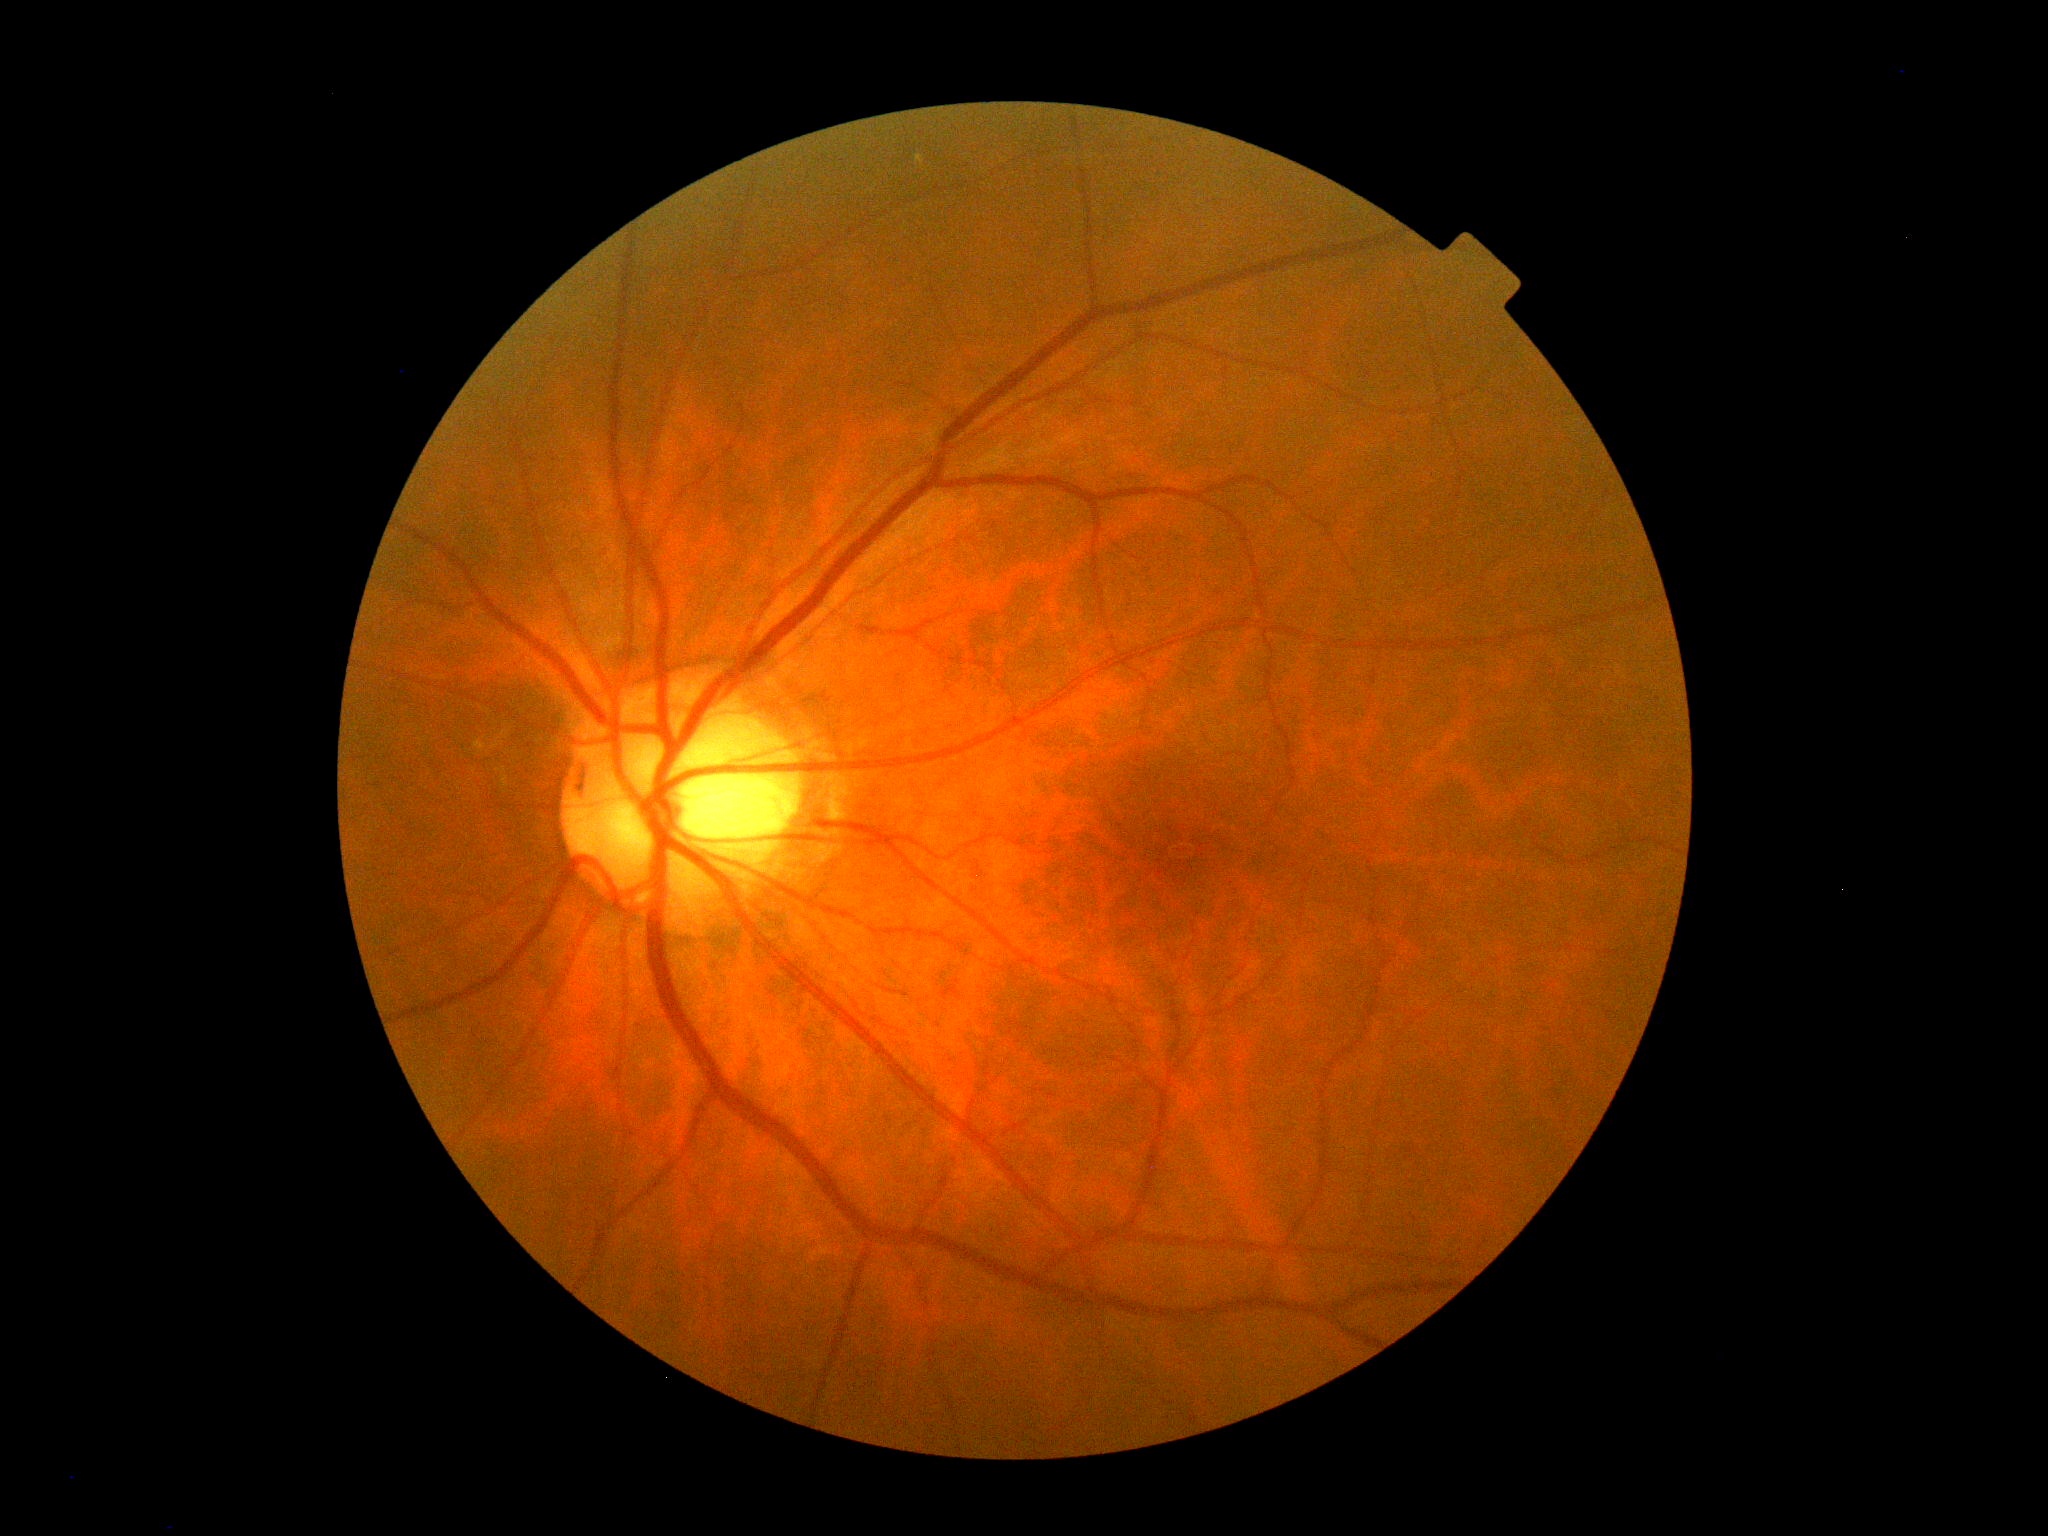

Diabetic retinopathy severity: 0/4.